Nonmydriatic fundus photograph · diabetic retinopathy graded by the modified Davis classification: 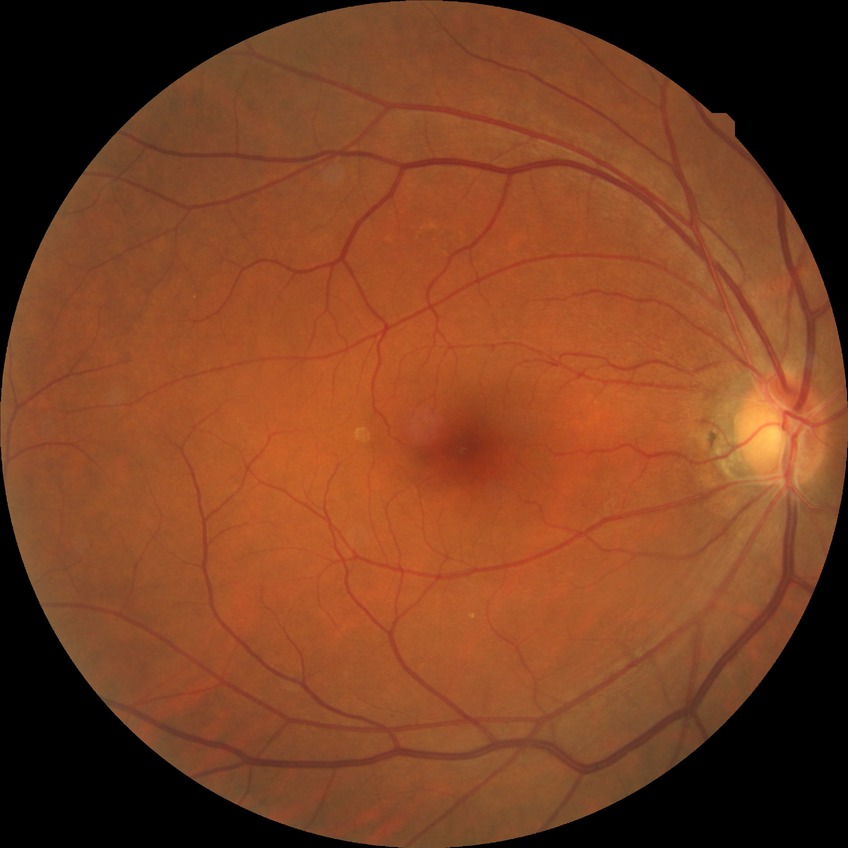 Diabetic retinopathy (DR) is NDR (no diabetic retinopathy).